Pediatric wide-field fundus photograph. 1240x1240 — 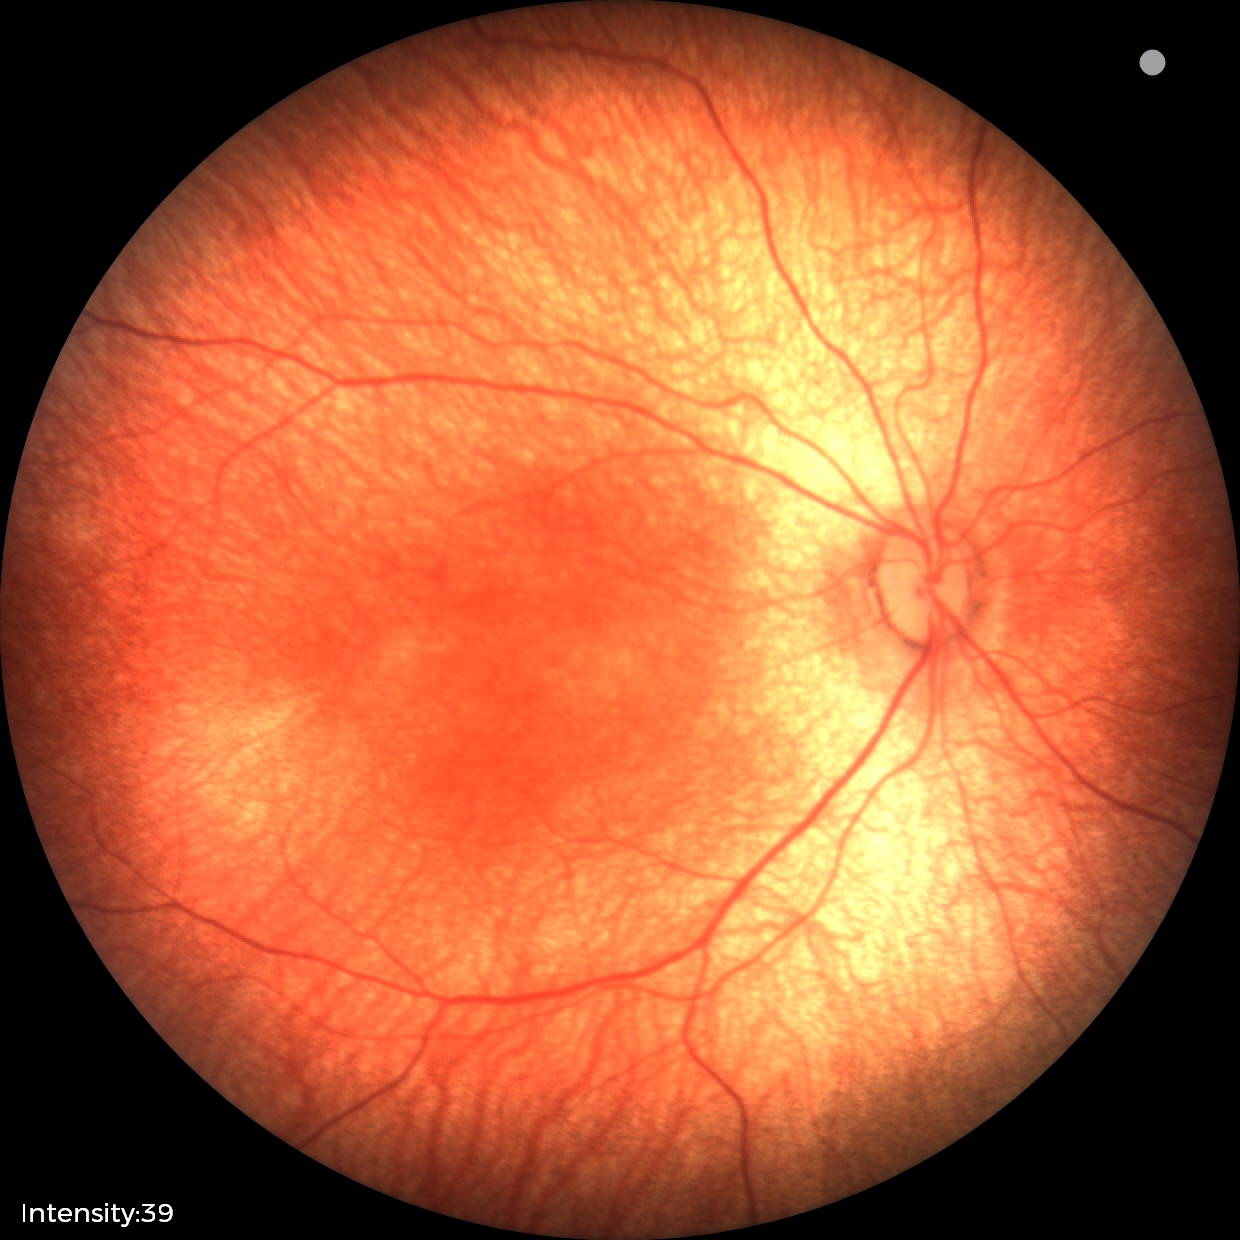 Finding = no abnormalities.